640x480px; wide-field fundus photograph of an infant:
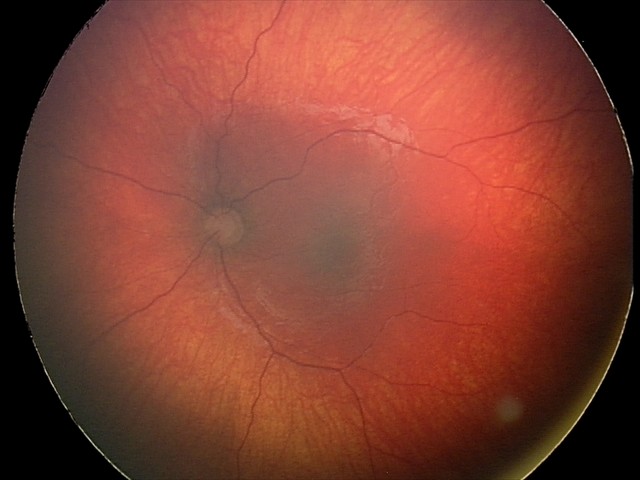
From an examination with diagnosis of optic nerve hypoplasia.